Retinal fundus photograph — 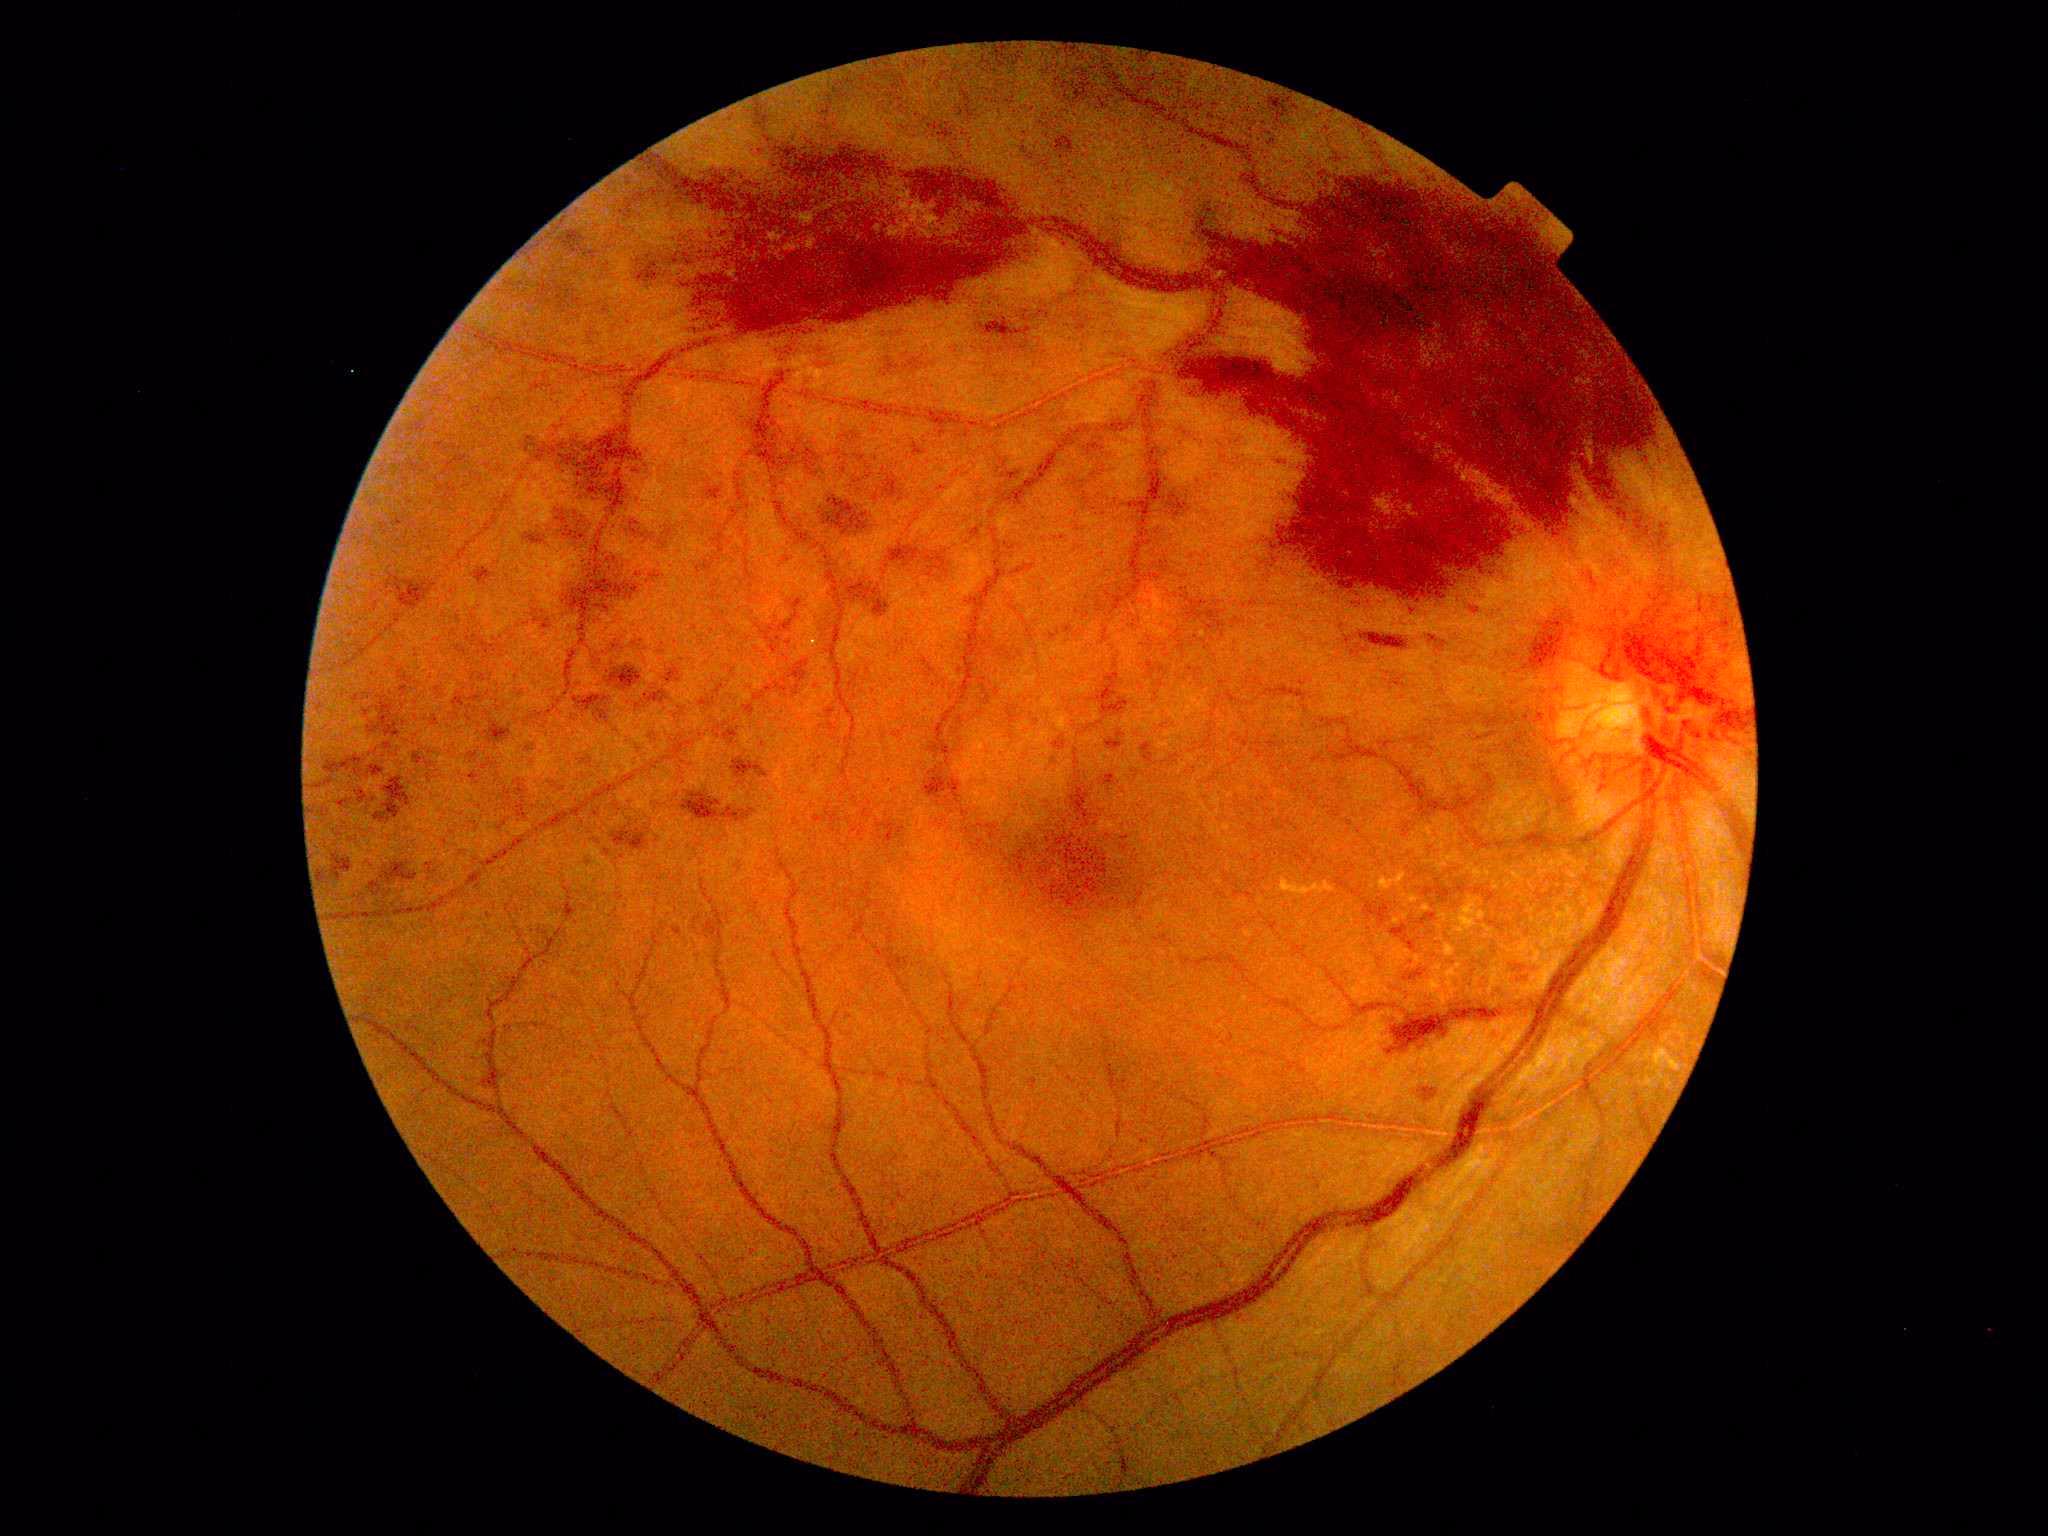
{
  "dr_grade": "grade 4 (PDR) — neovascularization and/or vitreous/pre-retinal hemorrhage"
}